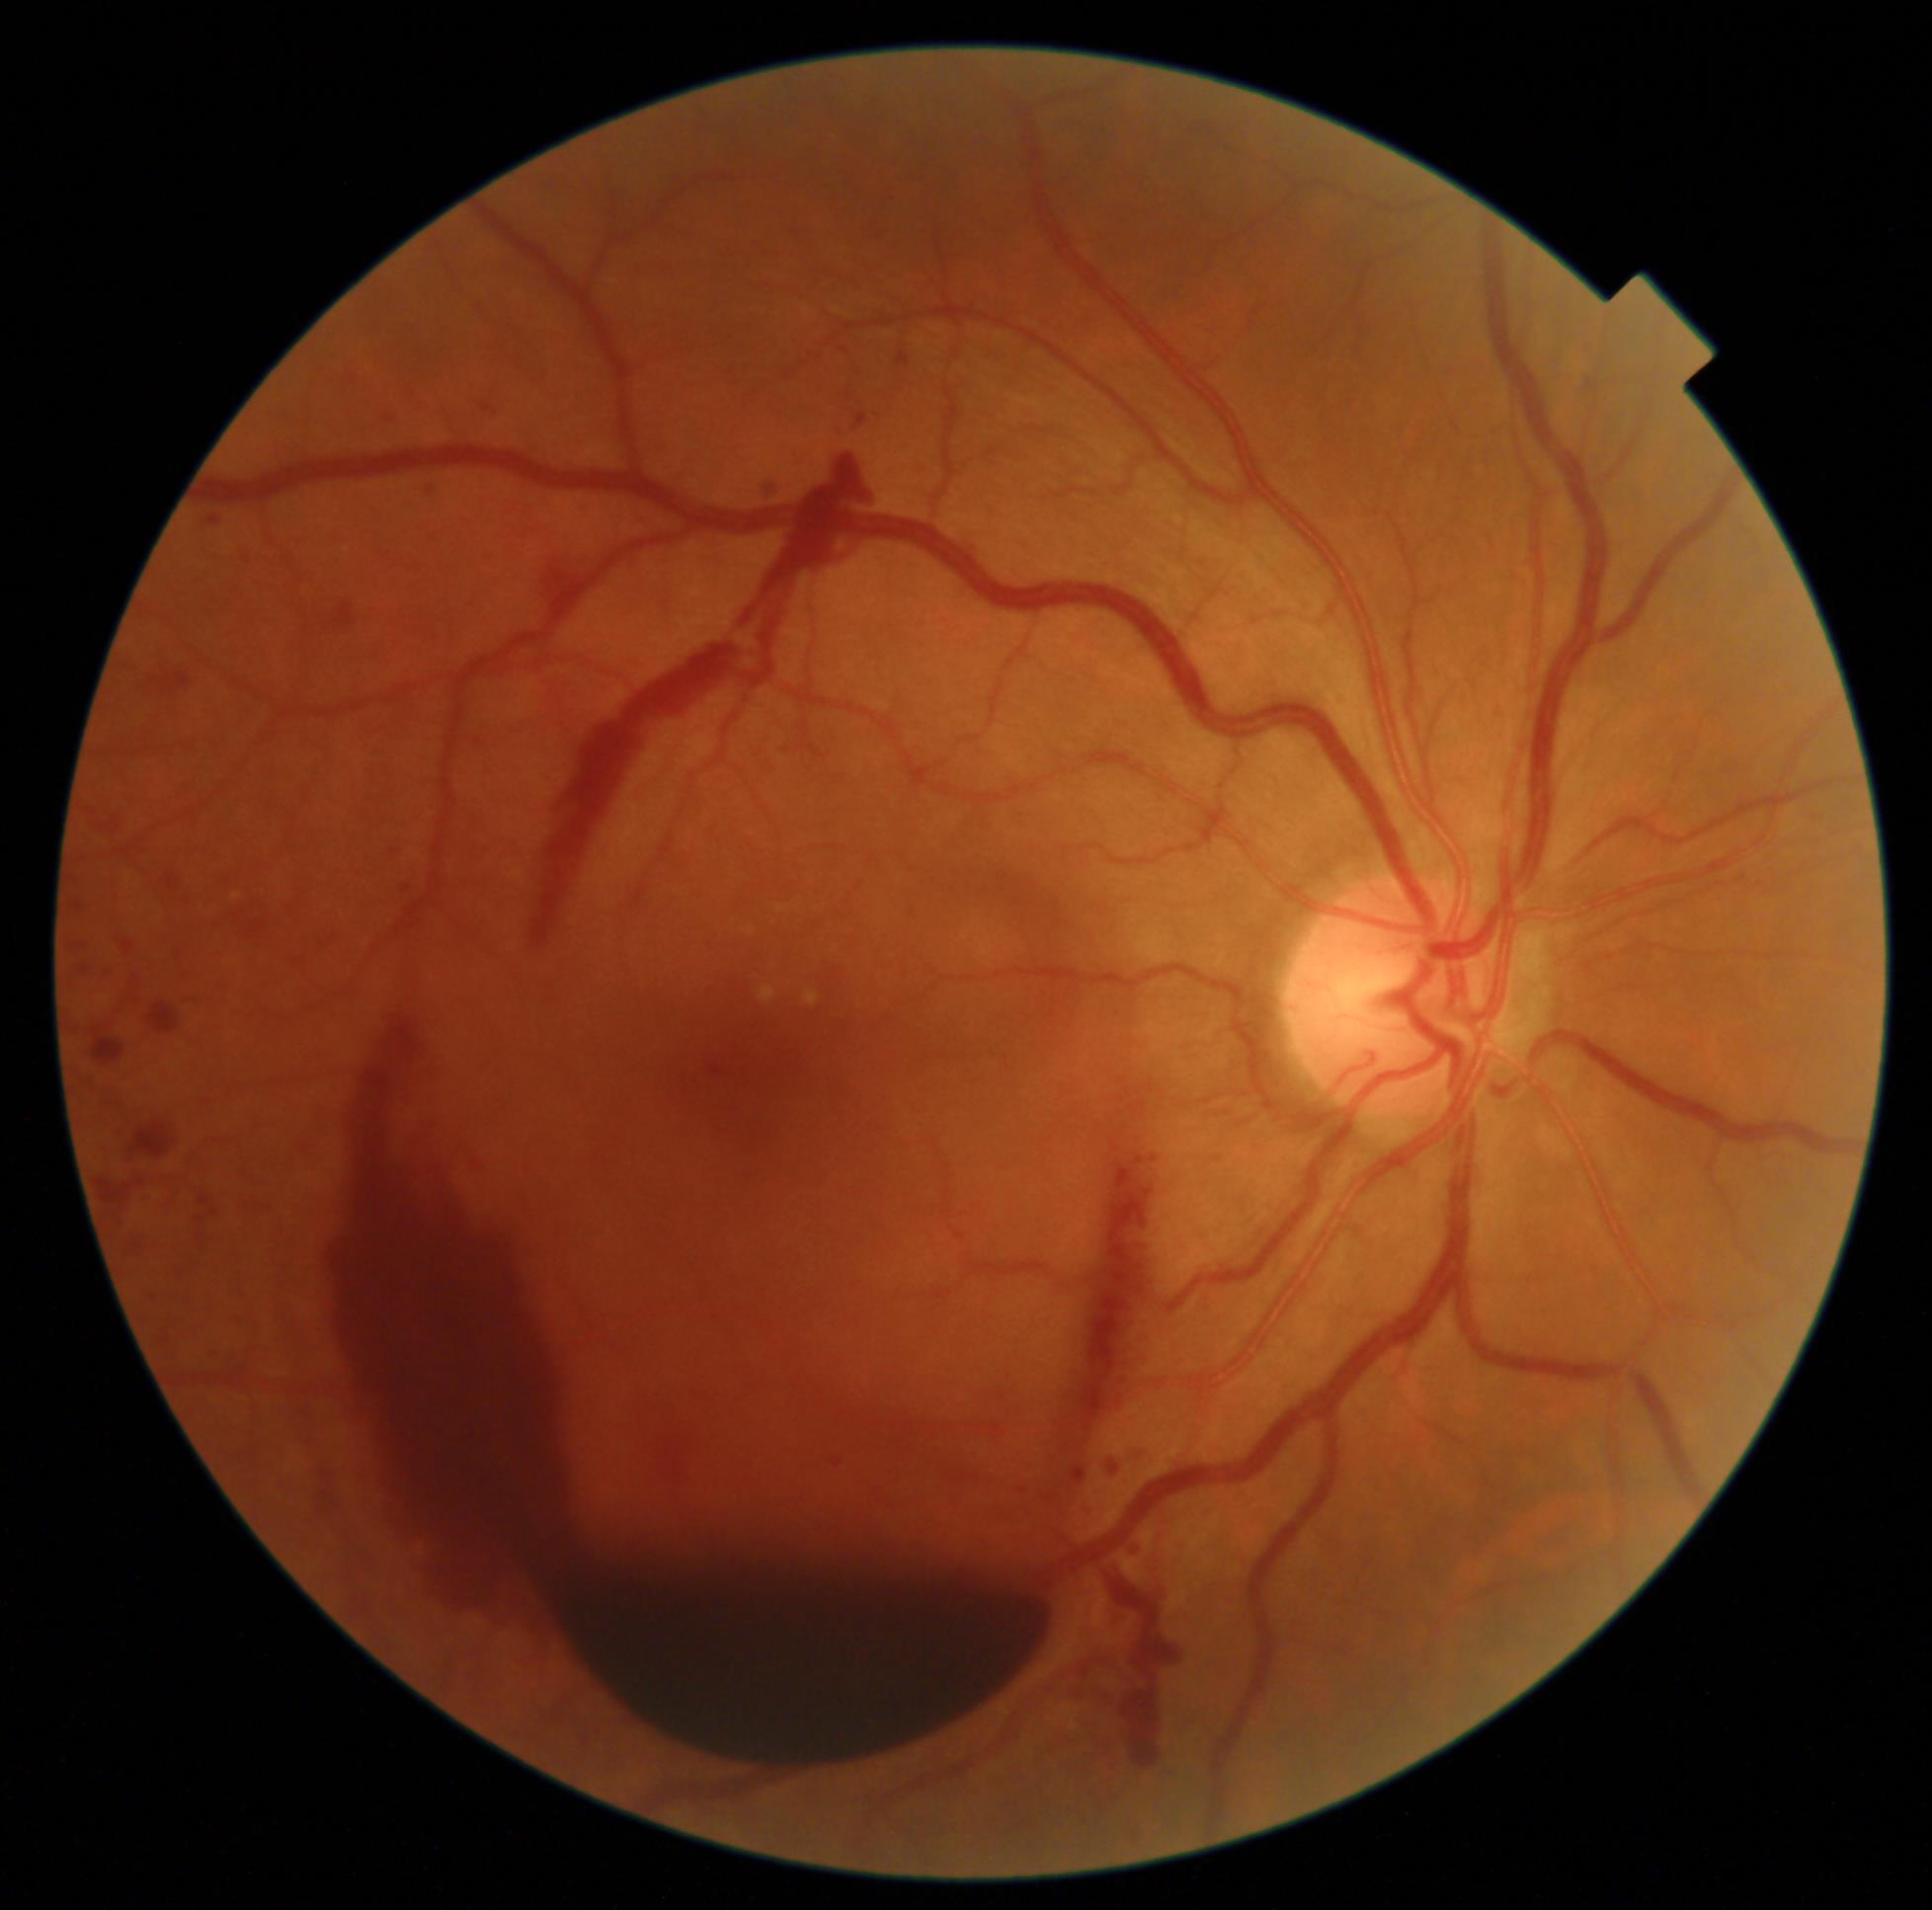
Diabetic retinopathy (DR) is grade 4.